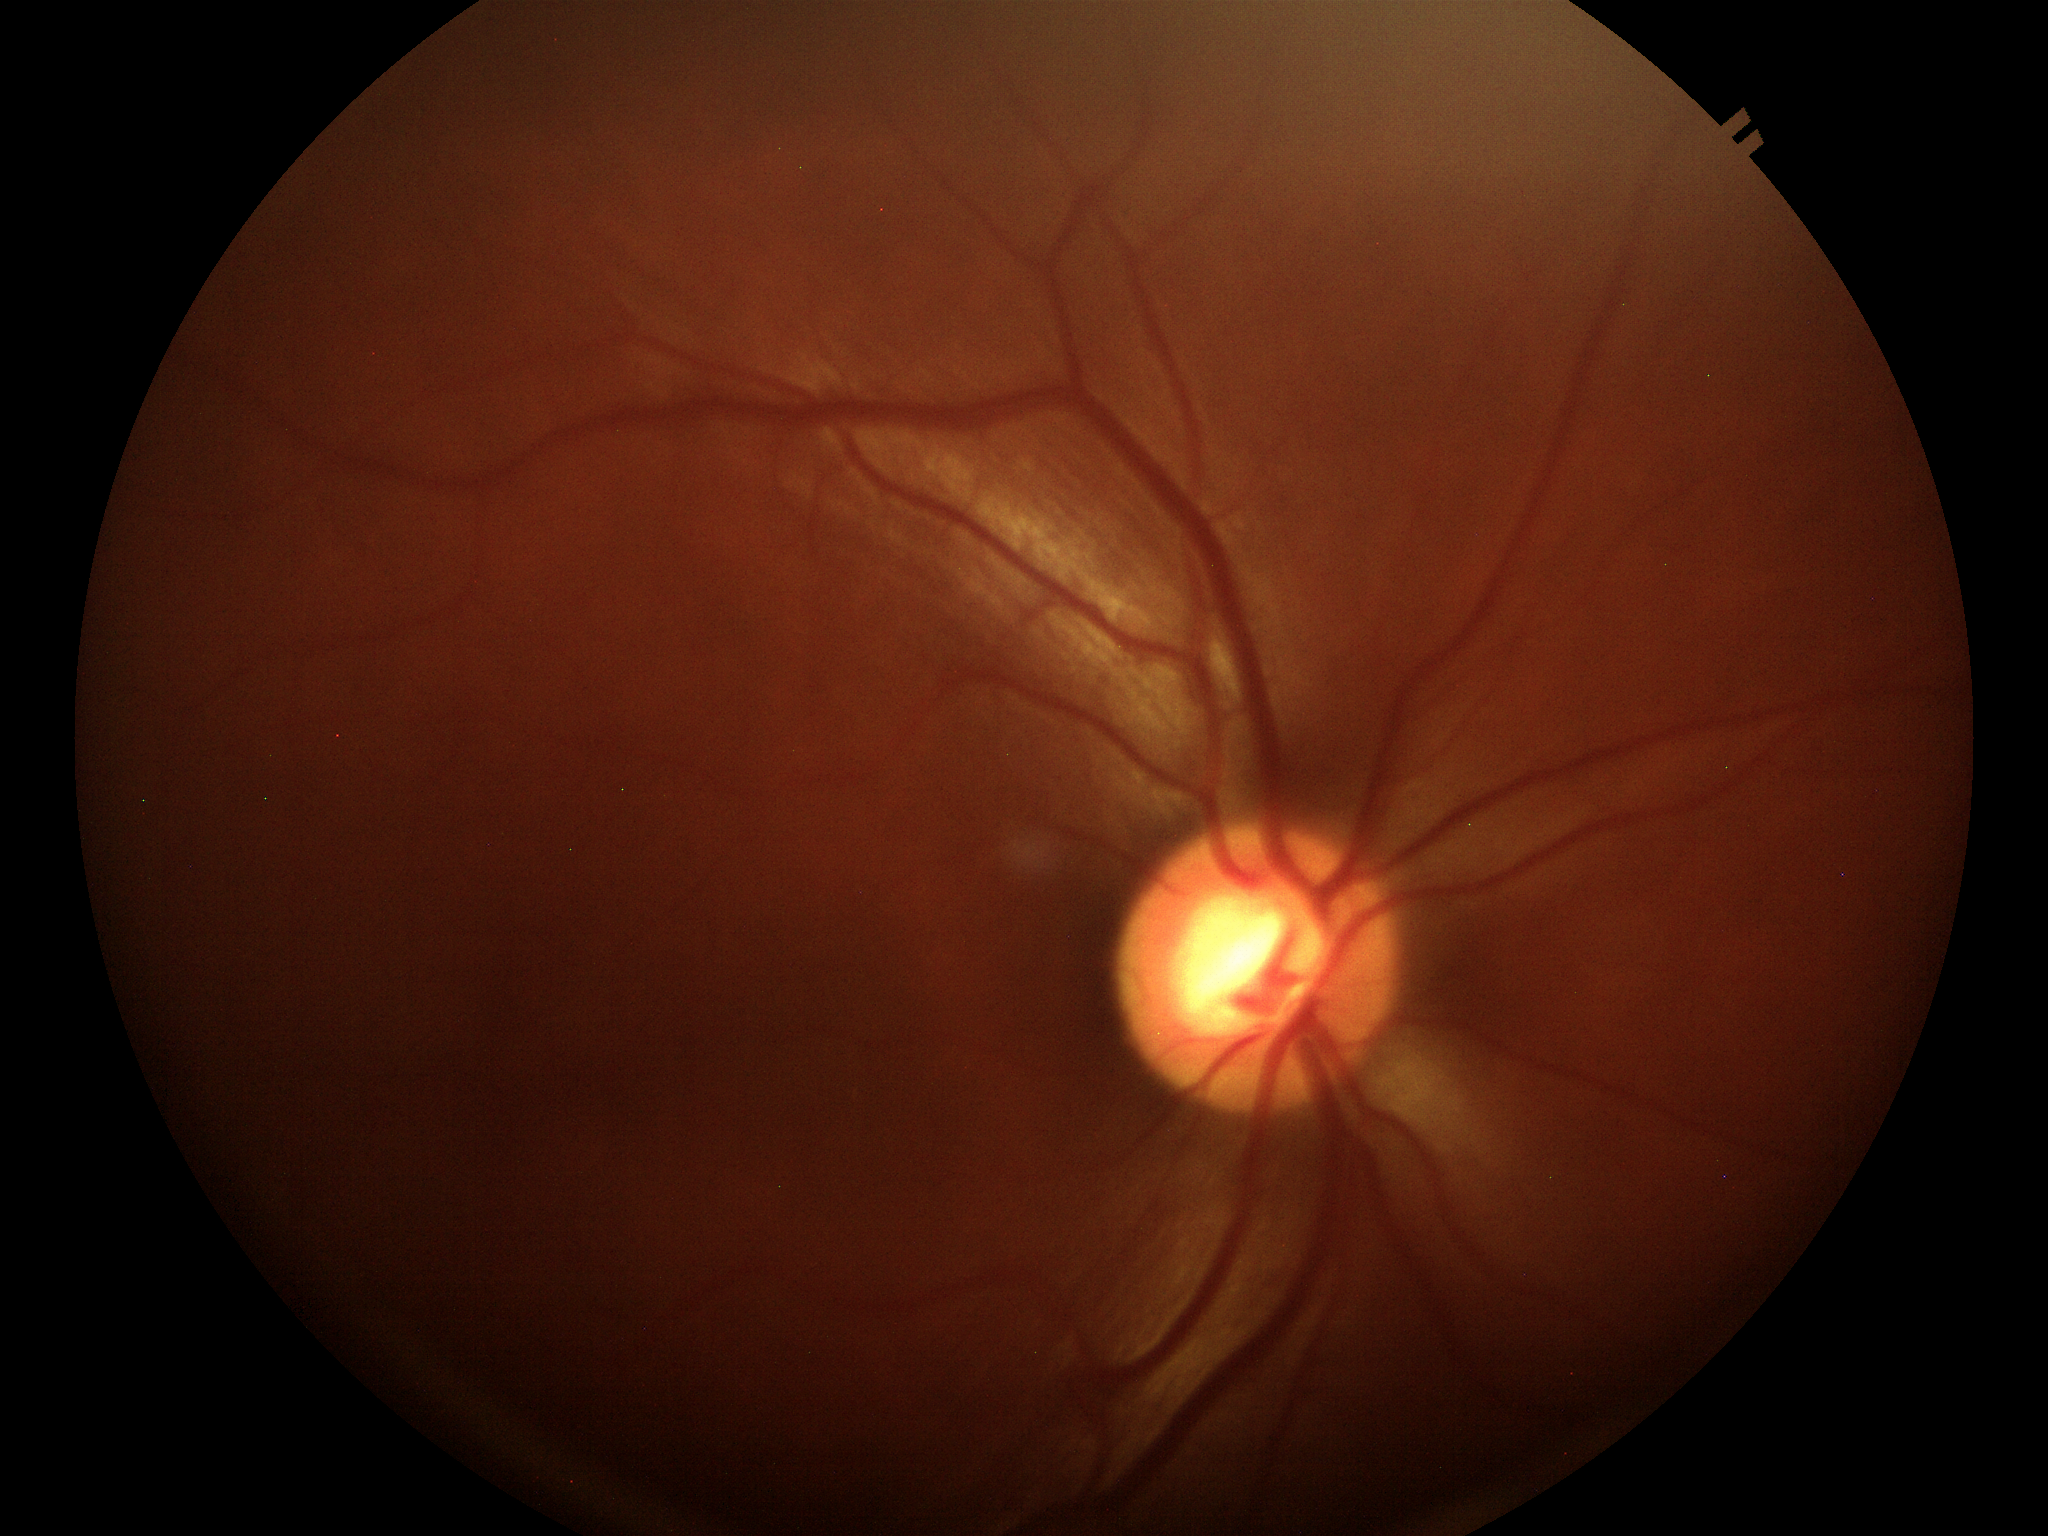

Glaucoma screening=suspicious findings; horizontal cup-disc ratio (HCDR)=0.61; vertical cup-disc ratio (VCDR)=0.60